Diabetic retinopathy graded by the modified Davis classification
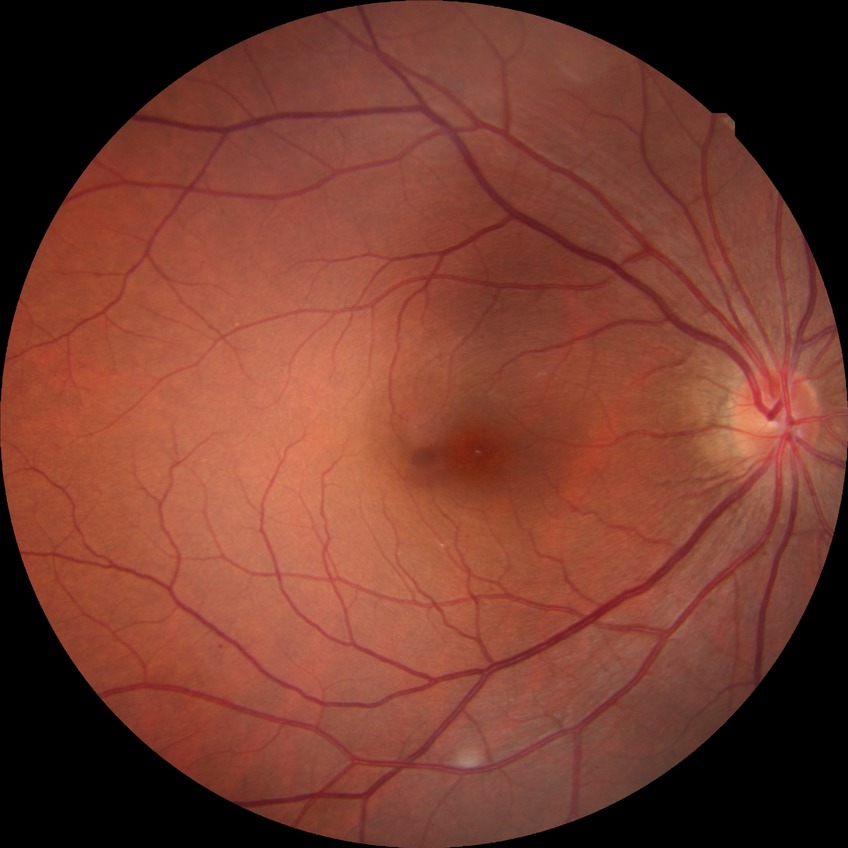

Diabetic retinopathy (DR) is NDR (no diabetic retinopathy).